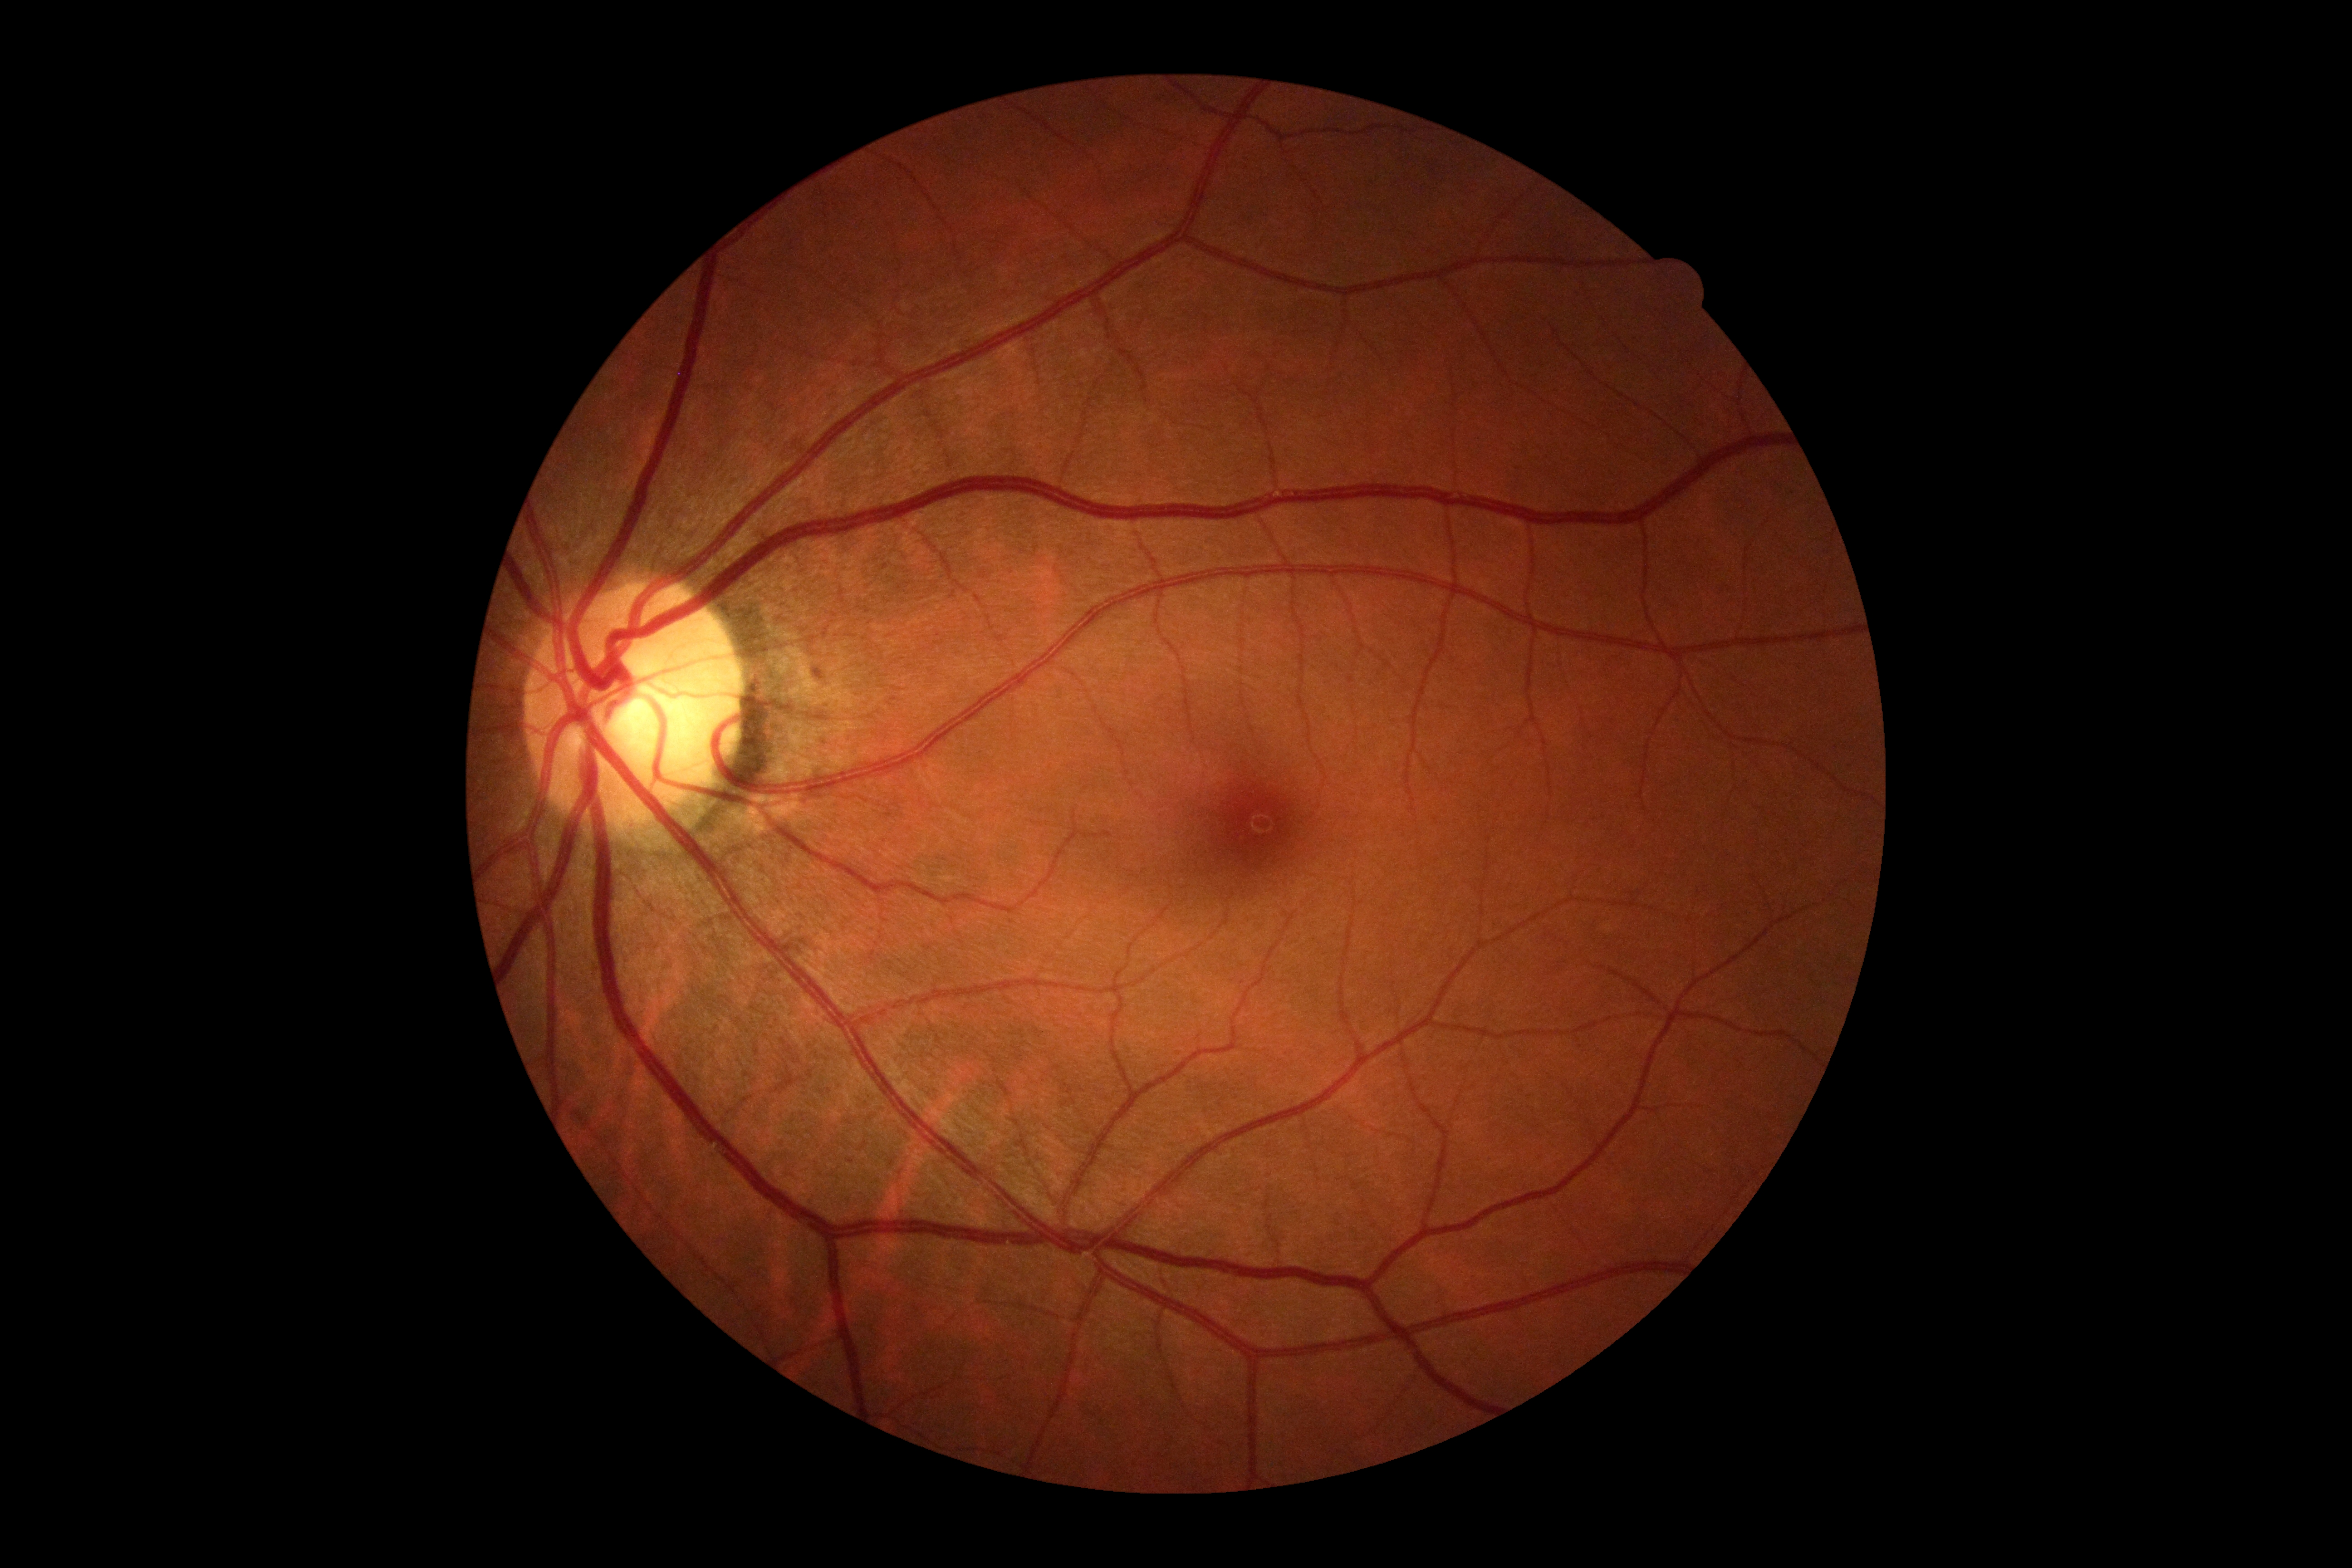
DR severity is grade 0.